Color fundus image:
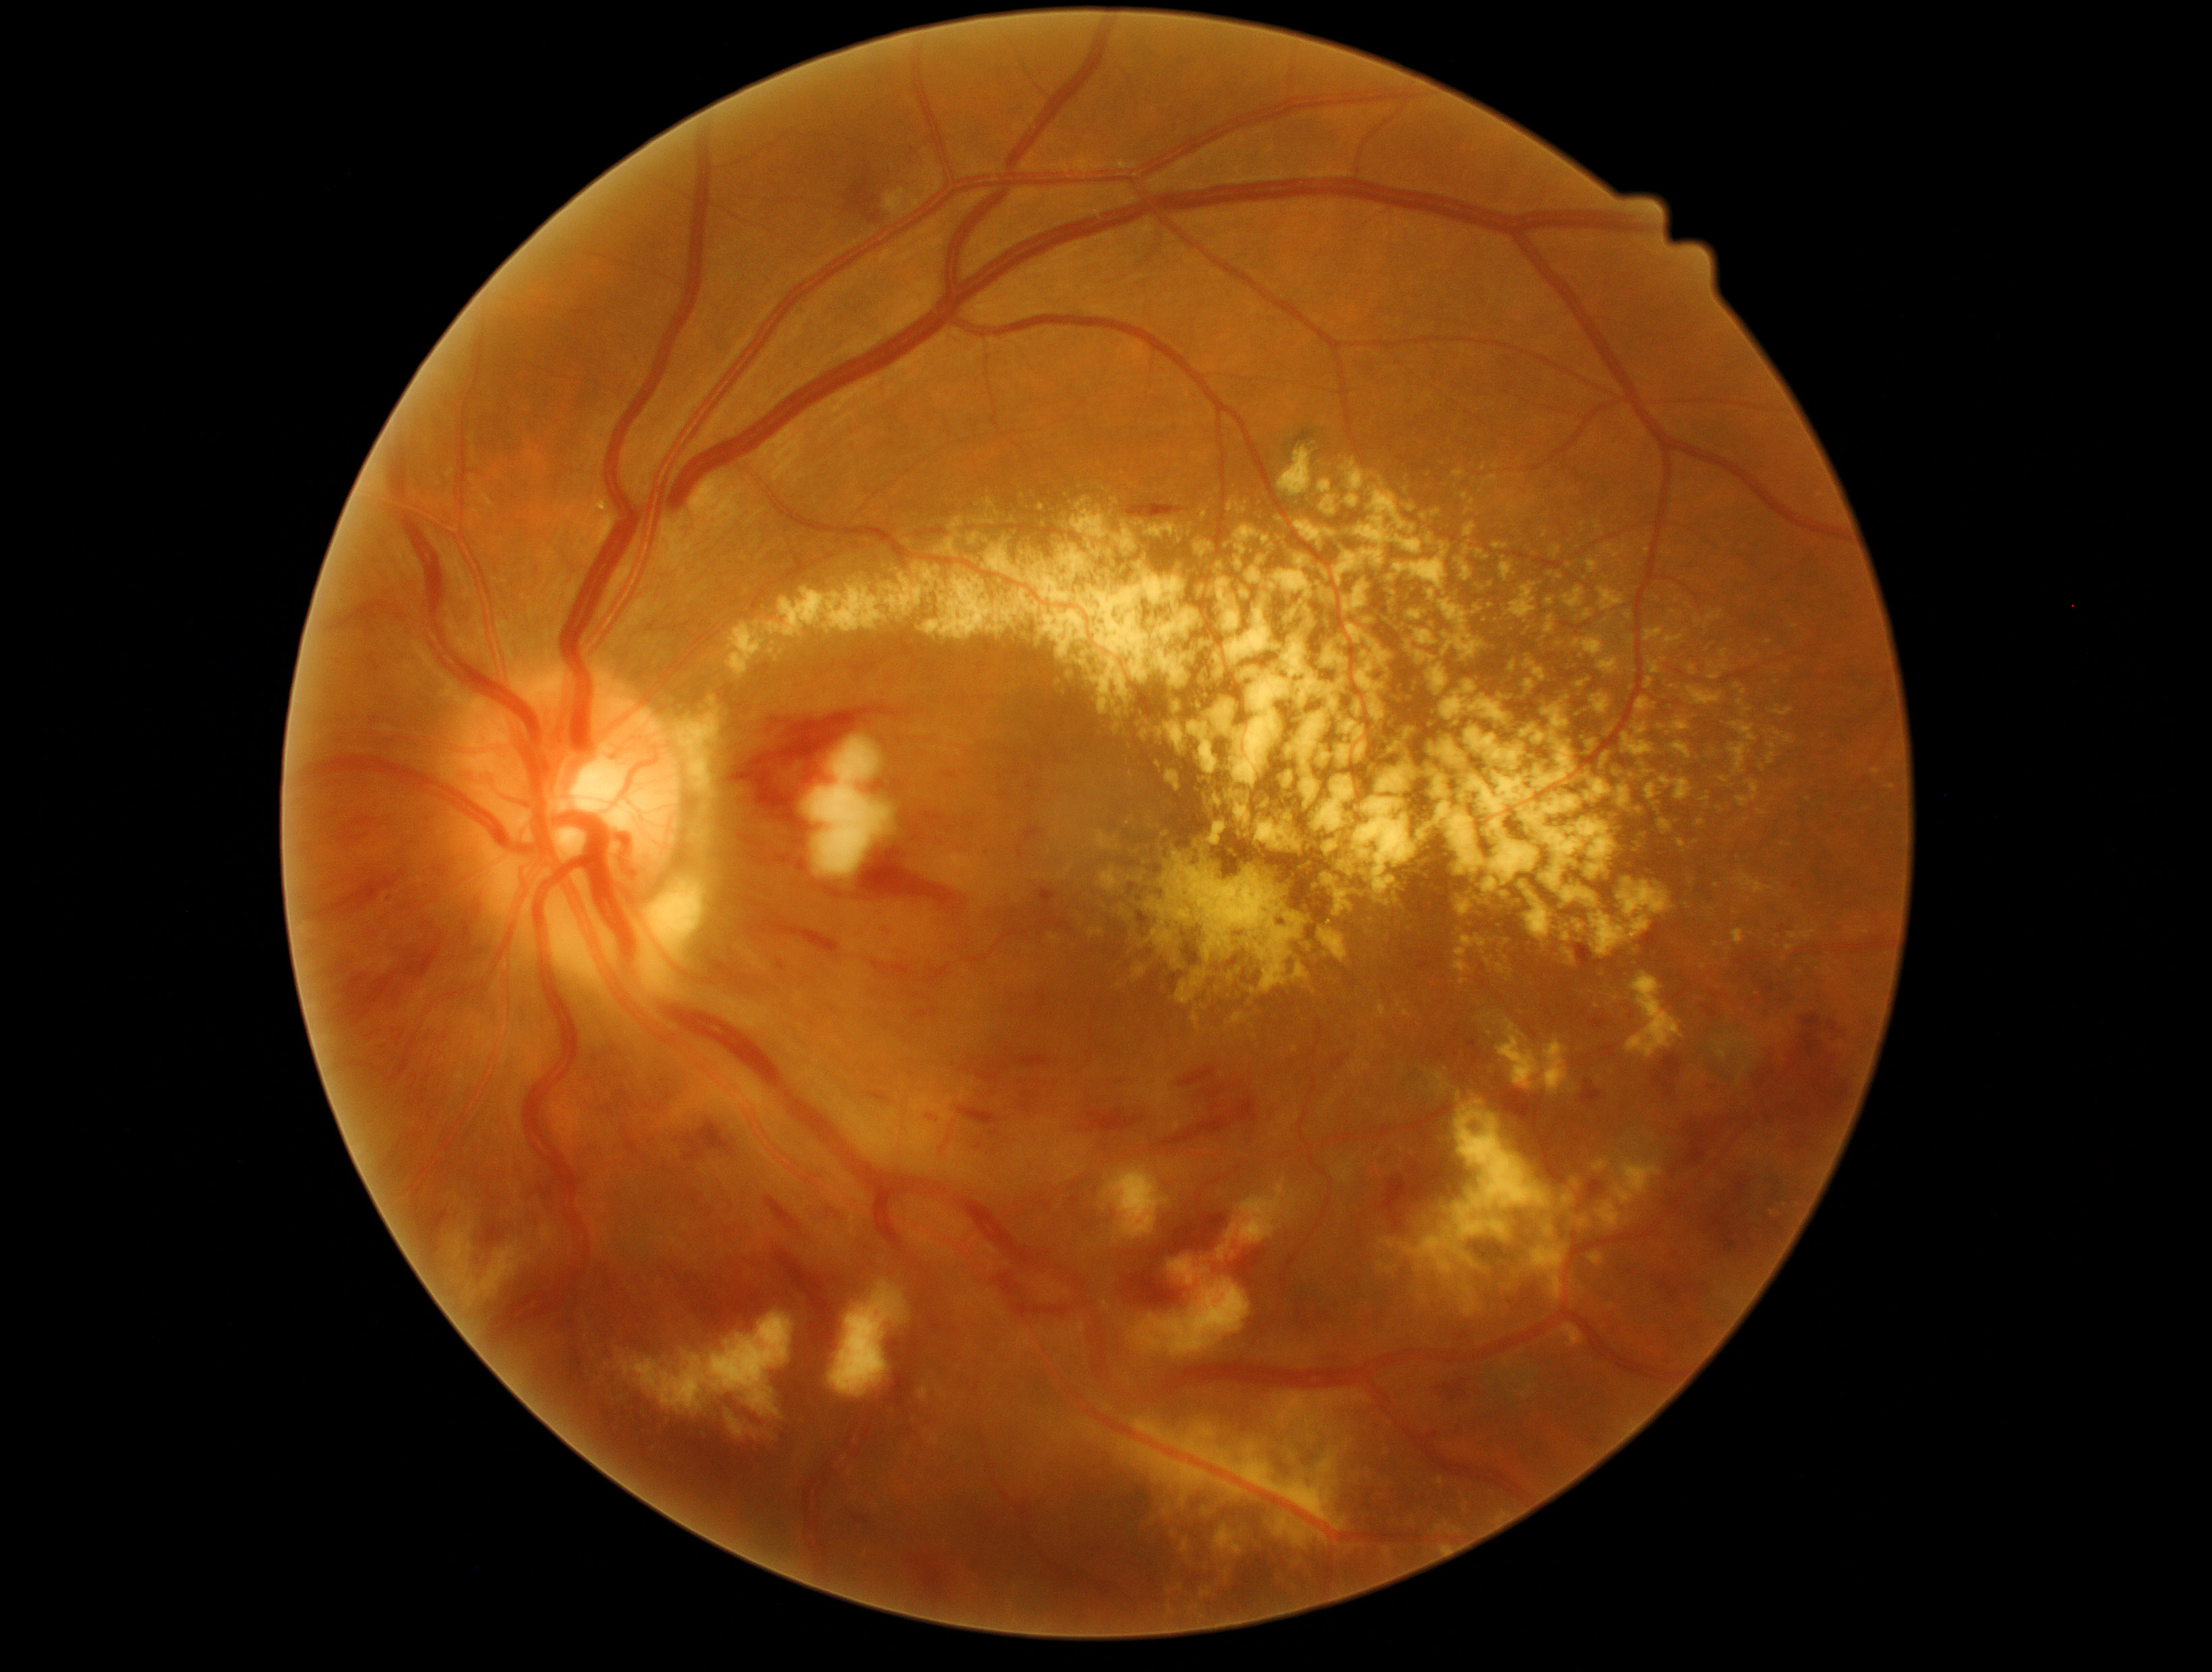

DR severity is severe NPDR (grade 3)
A subset of detected lesions:
EXs (subset): [x1=969, y1=533, x2=980, y2=545] | [x1=1224, y1=501, x2=1248, y2=514] | [x1=1785, y1=946, x2=1795, y2=951] | [x1=1320, y1=494, x2=1367, y2=520] | [x1=1464, y1=489, x2=1483, y2=518] | [x1=1544, y1=1220, x2=1554, y2=1241] | [x1=1480, y1=1013, x2=1492, y2=1021] | [x1=1781, y1=843, x2=1789, y2=847] | [x1=1724, y1=682, x2=1751, y2=784] | [x1=1157, y1=1492, x2=1188, y2=1554] | [x1=1693, y1=610, x2=1724, y2=640] | [x1=1711, y1=655, x2=1727, y2=683] | [x1=1645, y1=629, x2=1685, y2=647] | [x1=1192, y1=695, x2=1345, y2=839] | [x1=1544, y1=616, x2=1554, y2=641] | [x1=1154, y1=757, x2=1163, y2=777] | [x1=1403, y1=1011, x2=1413, y2=1019] | [x1=1494, y1=1016, x2=1569, y2=1094]
EXs (small, approximate centers) near {"x": 1761, "y": 769}